1240x1240. Phoenix ICON, 100° FOV. Phoenix ICON wide-field infant fundus image.
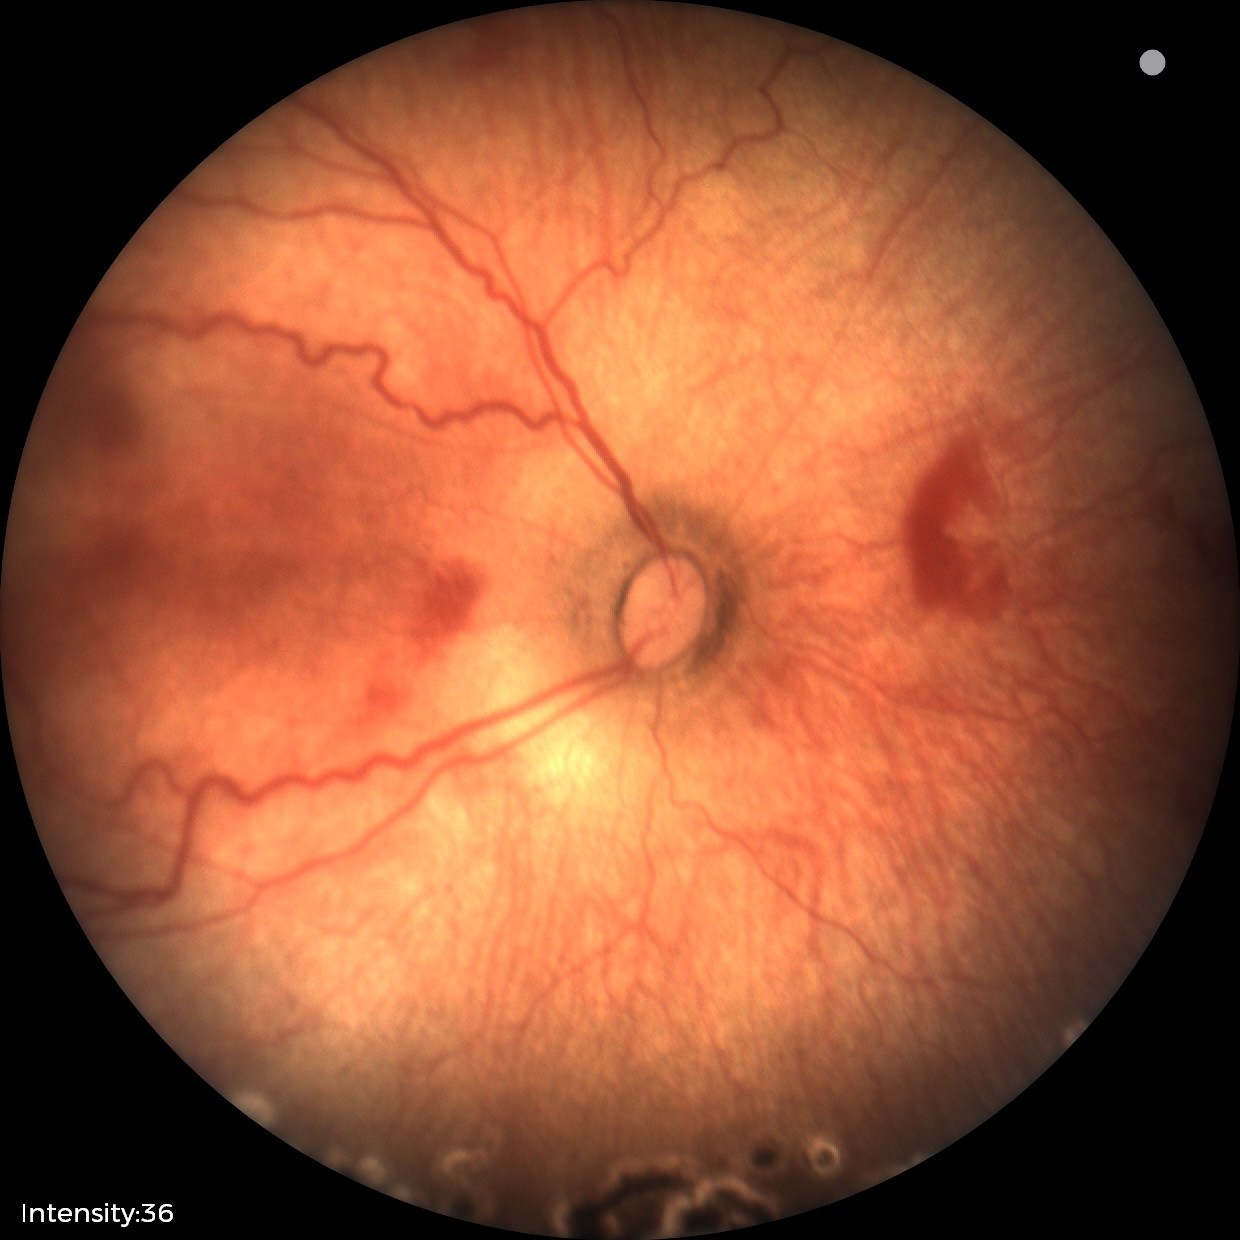
Series diagnosed as status post ROP.
No plus disease.